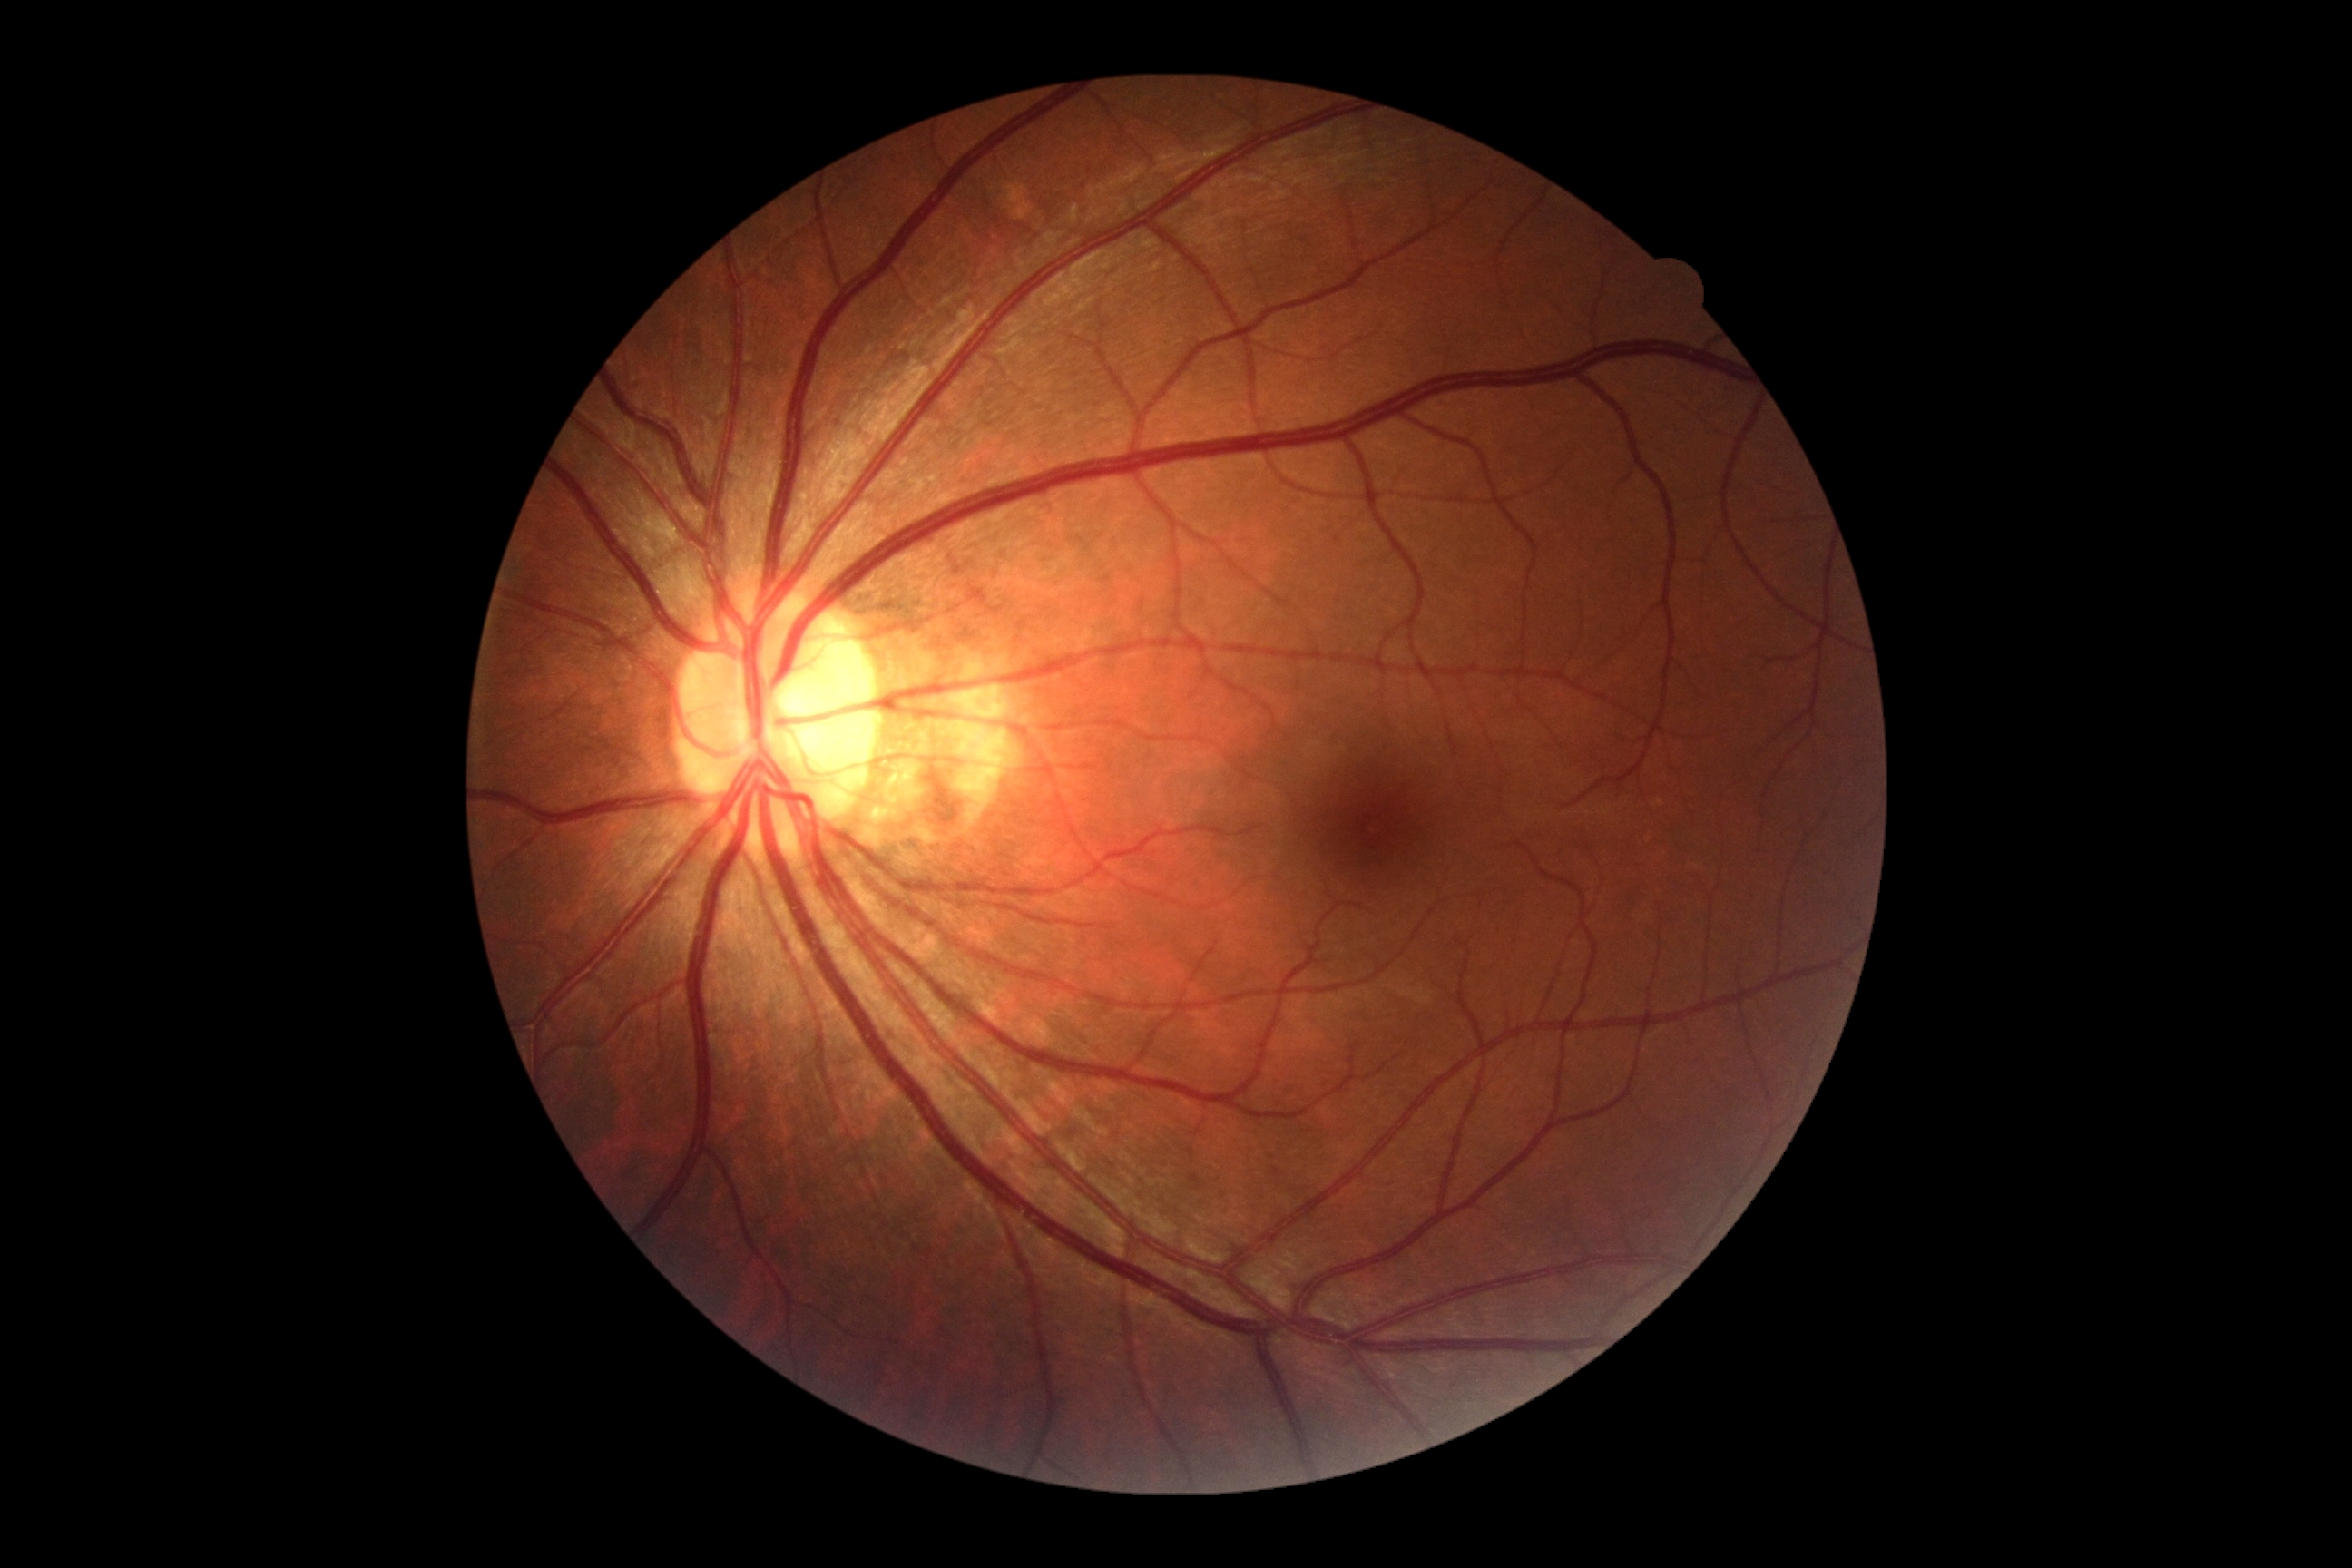

DR impression = no apparent DR
diabetic retinopathy (DR) = grade 0 (no apparent retinopathy)